Wide-field fundus image from infant ROP screening — 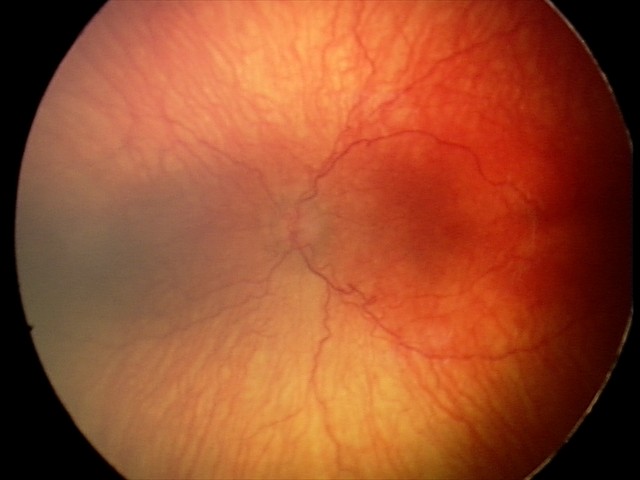

From an examination with diagnosis of aggressive ROP (A-ROP).